Disc-centered field — 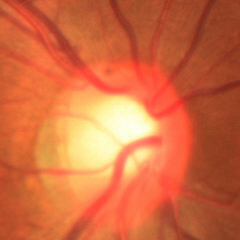

Q: Does this eye have glaucoma?
A: No glaucoma.